Image size 640x480; Clarity RetCam 3, 130° FOV; RetCam wide-field infant fundus image.
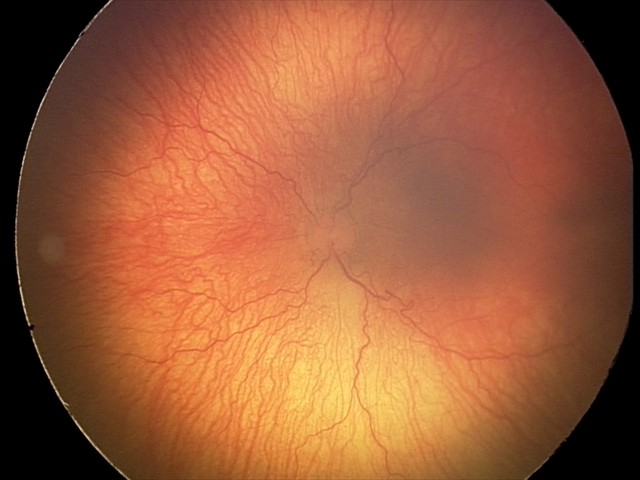 Screening diagnosis: aggressive retinopathy of prematurity (A-ROP) — rapidly progressive severe ROP with prominent plus disease, often without classic stage progression.